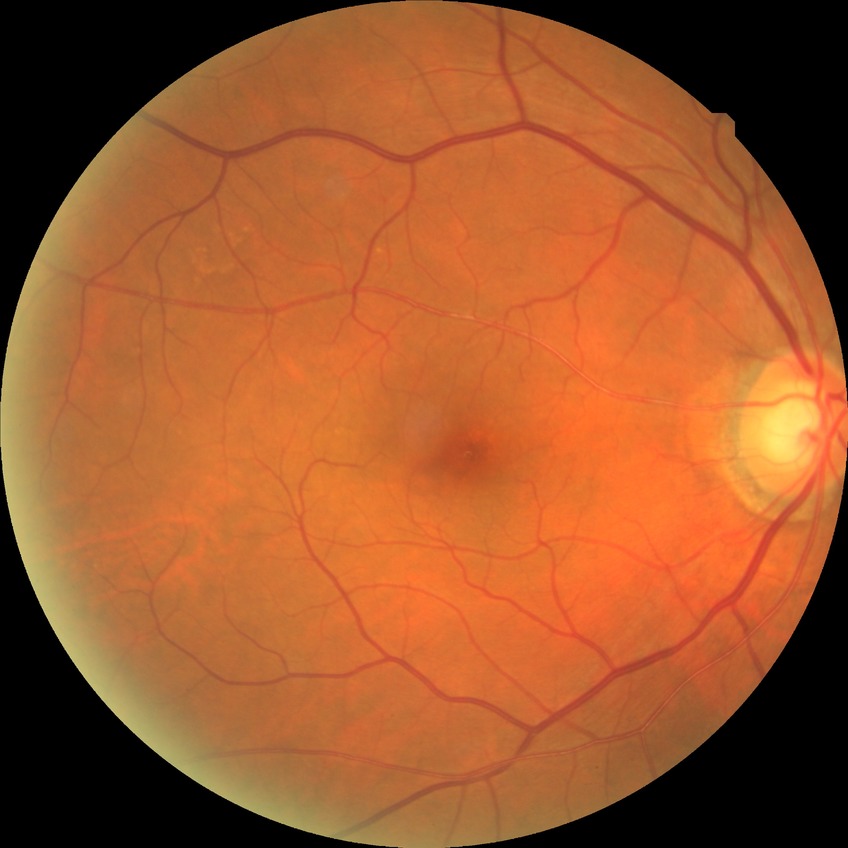

Diabetic retinopathy severity: no diabetic retinopathy.